2089x1764px; CFP — 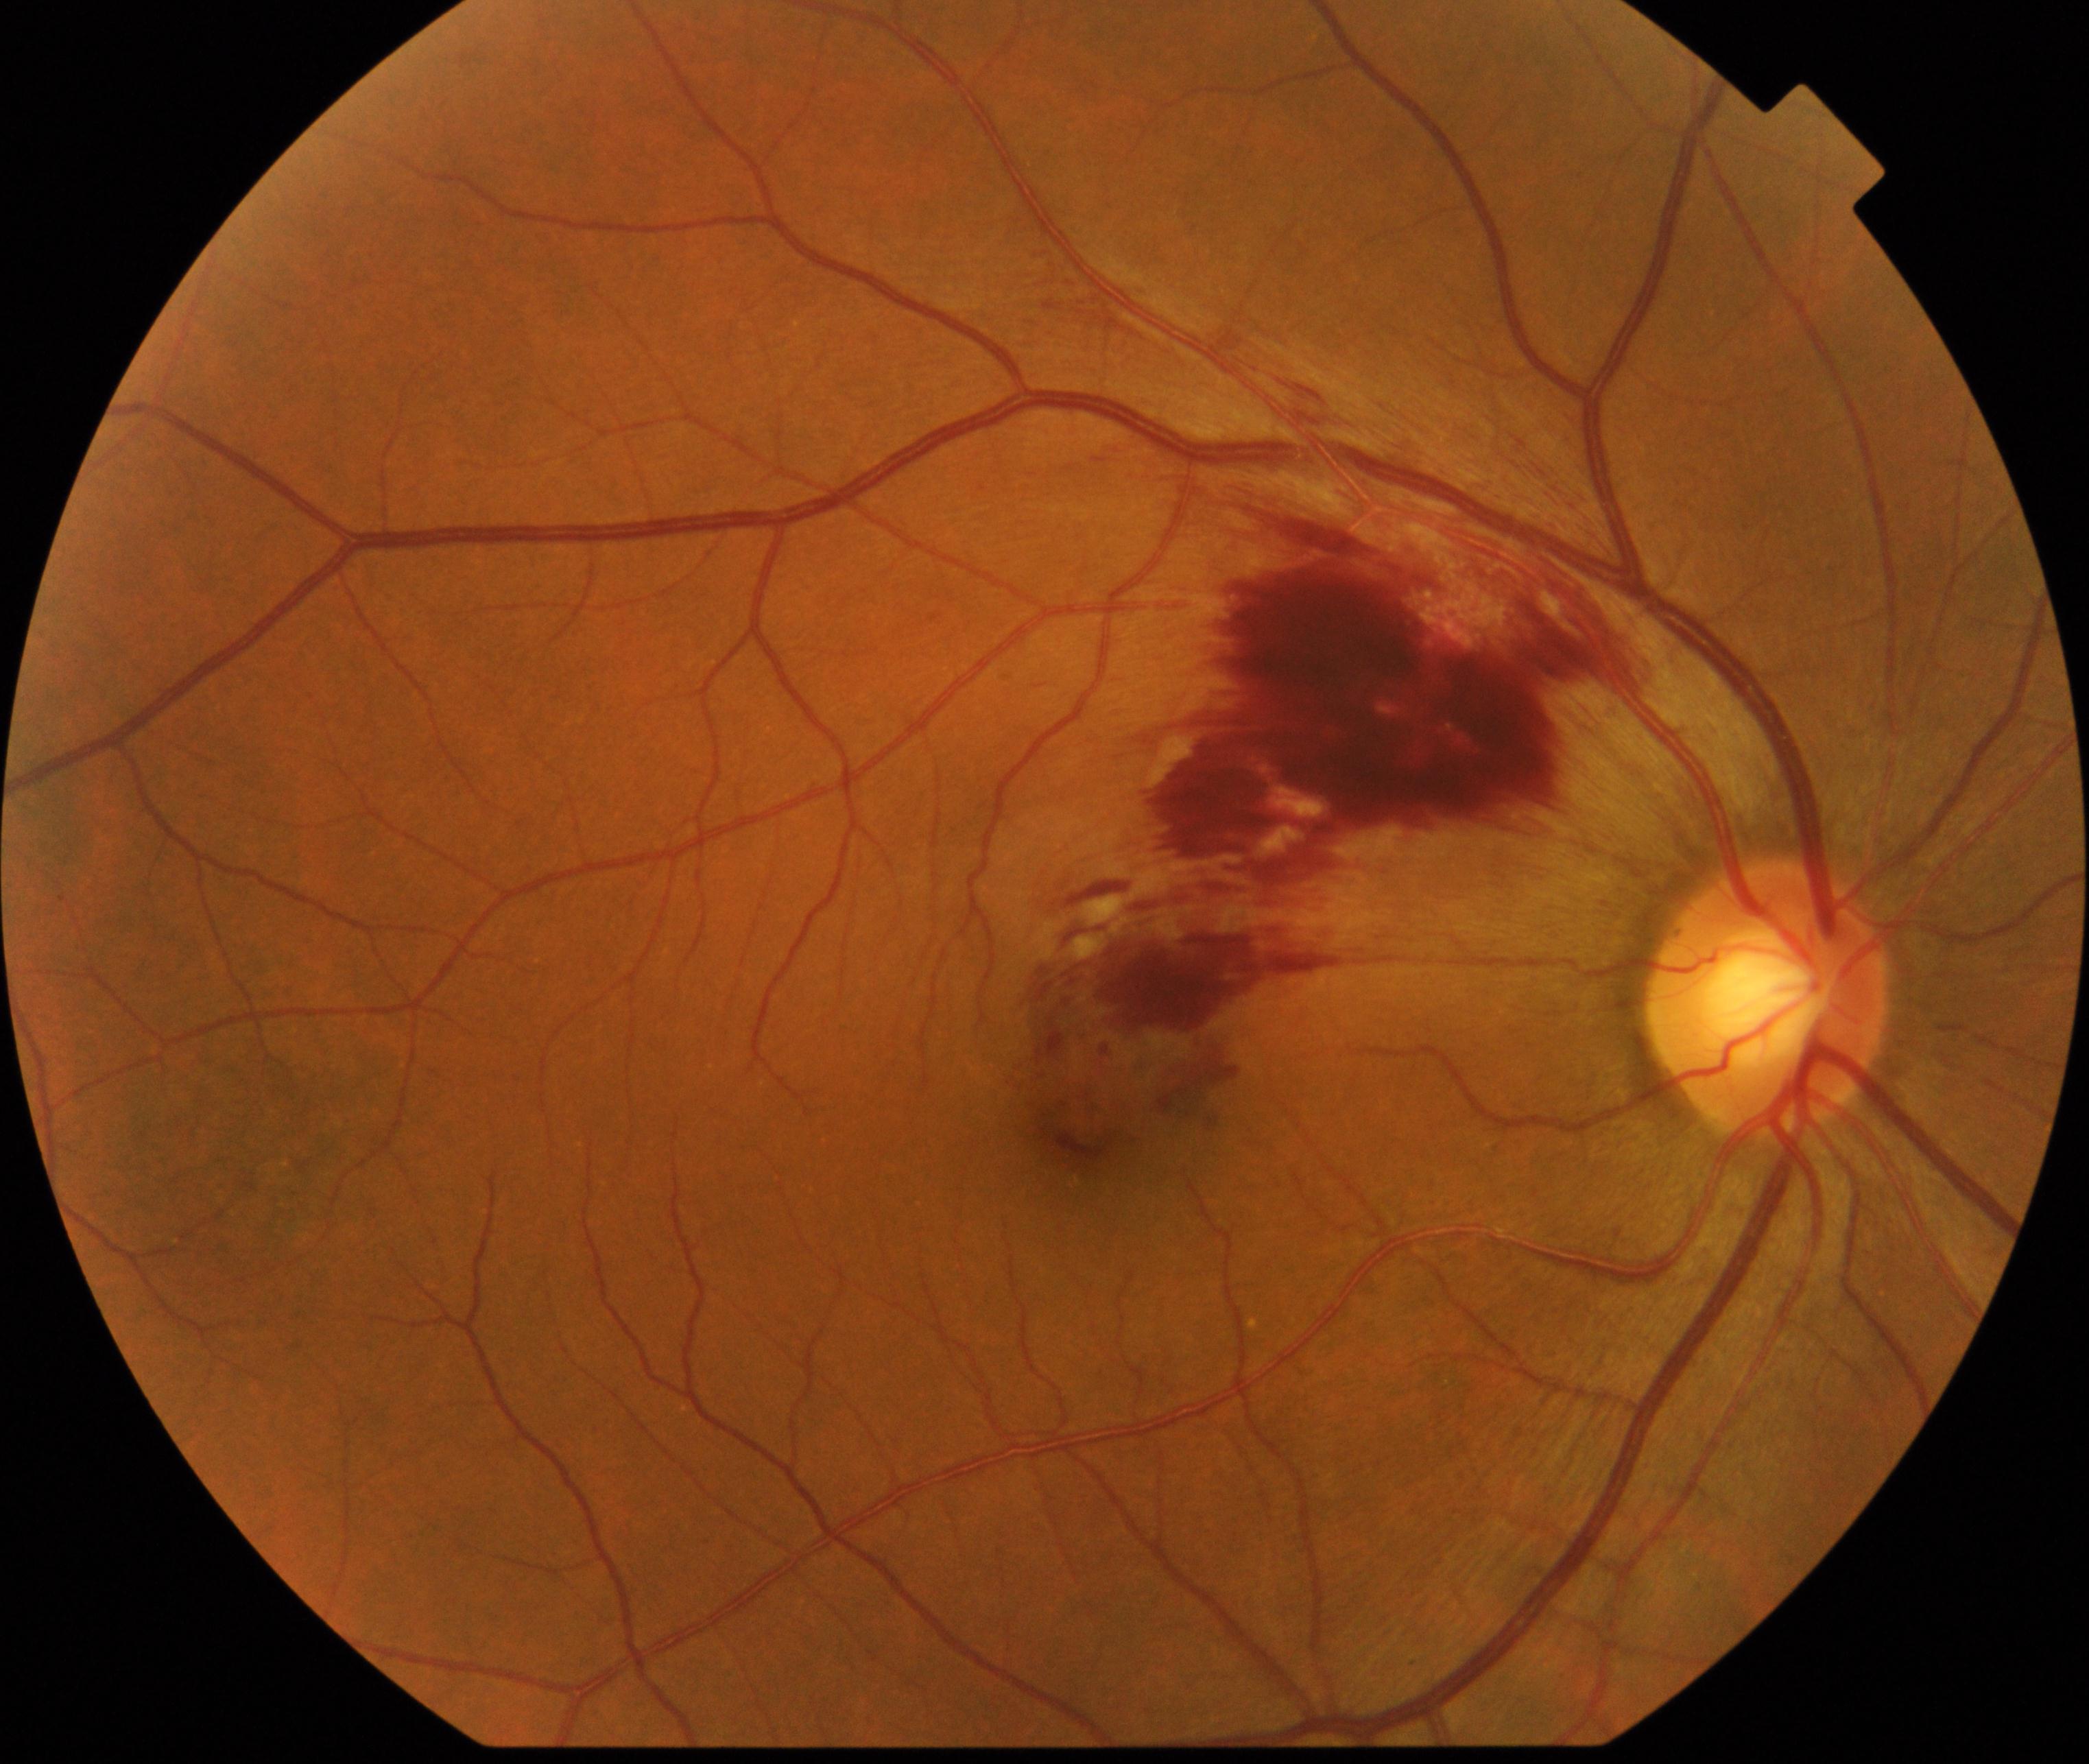

Impression: branch retinal vein occlusion (BRVO).